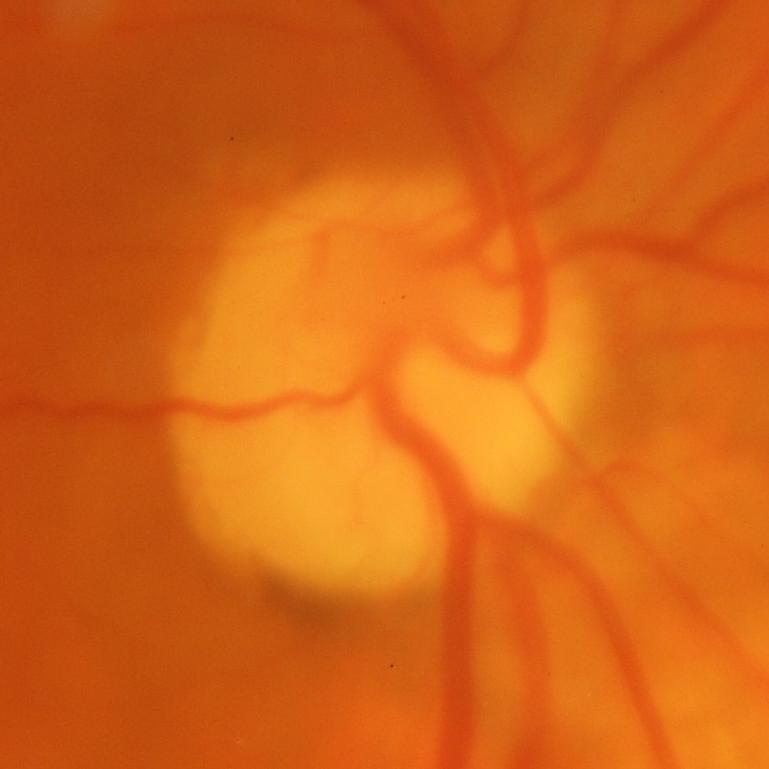
Evidence of glaucoma.